Axial length: 22.73 mm. Woman.
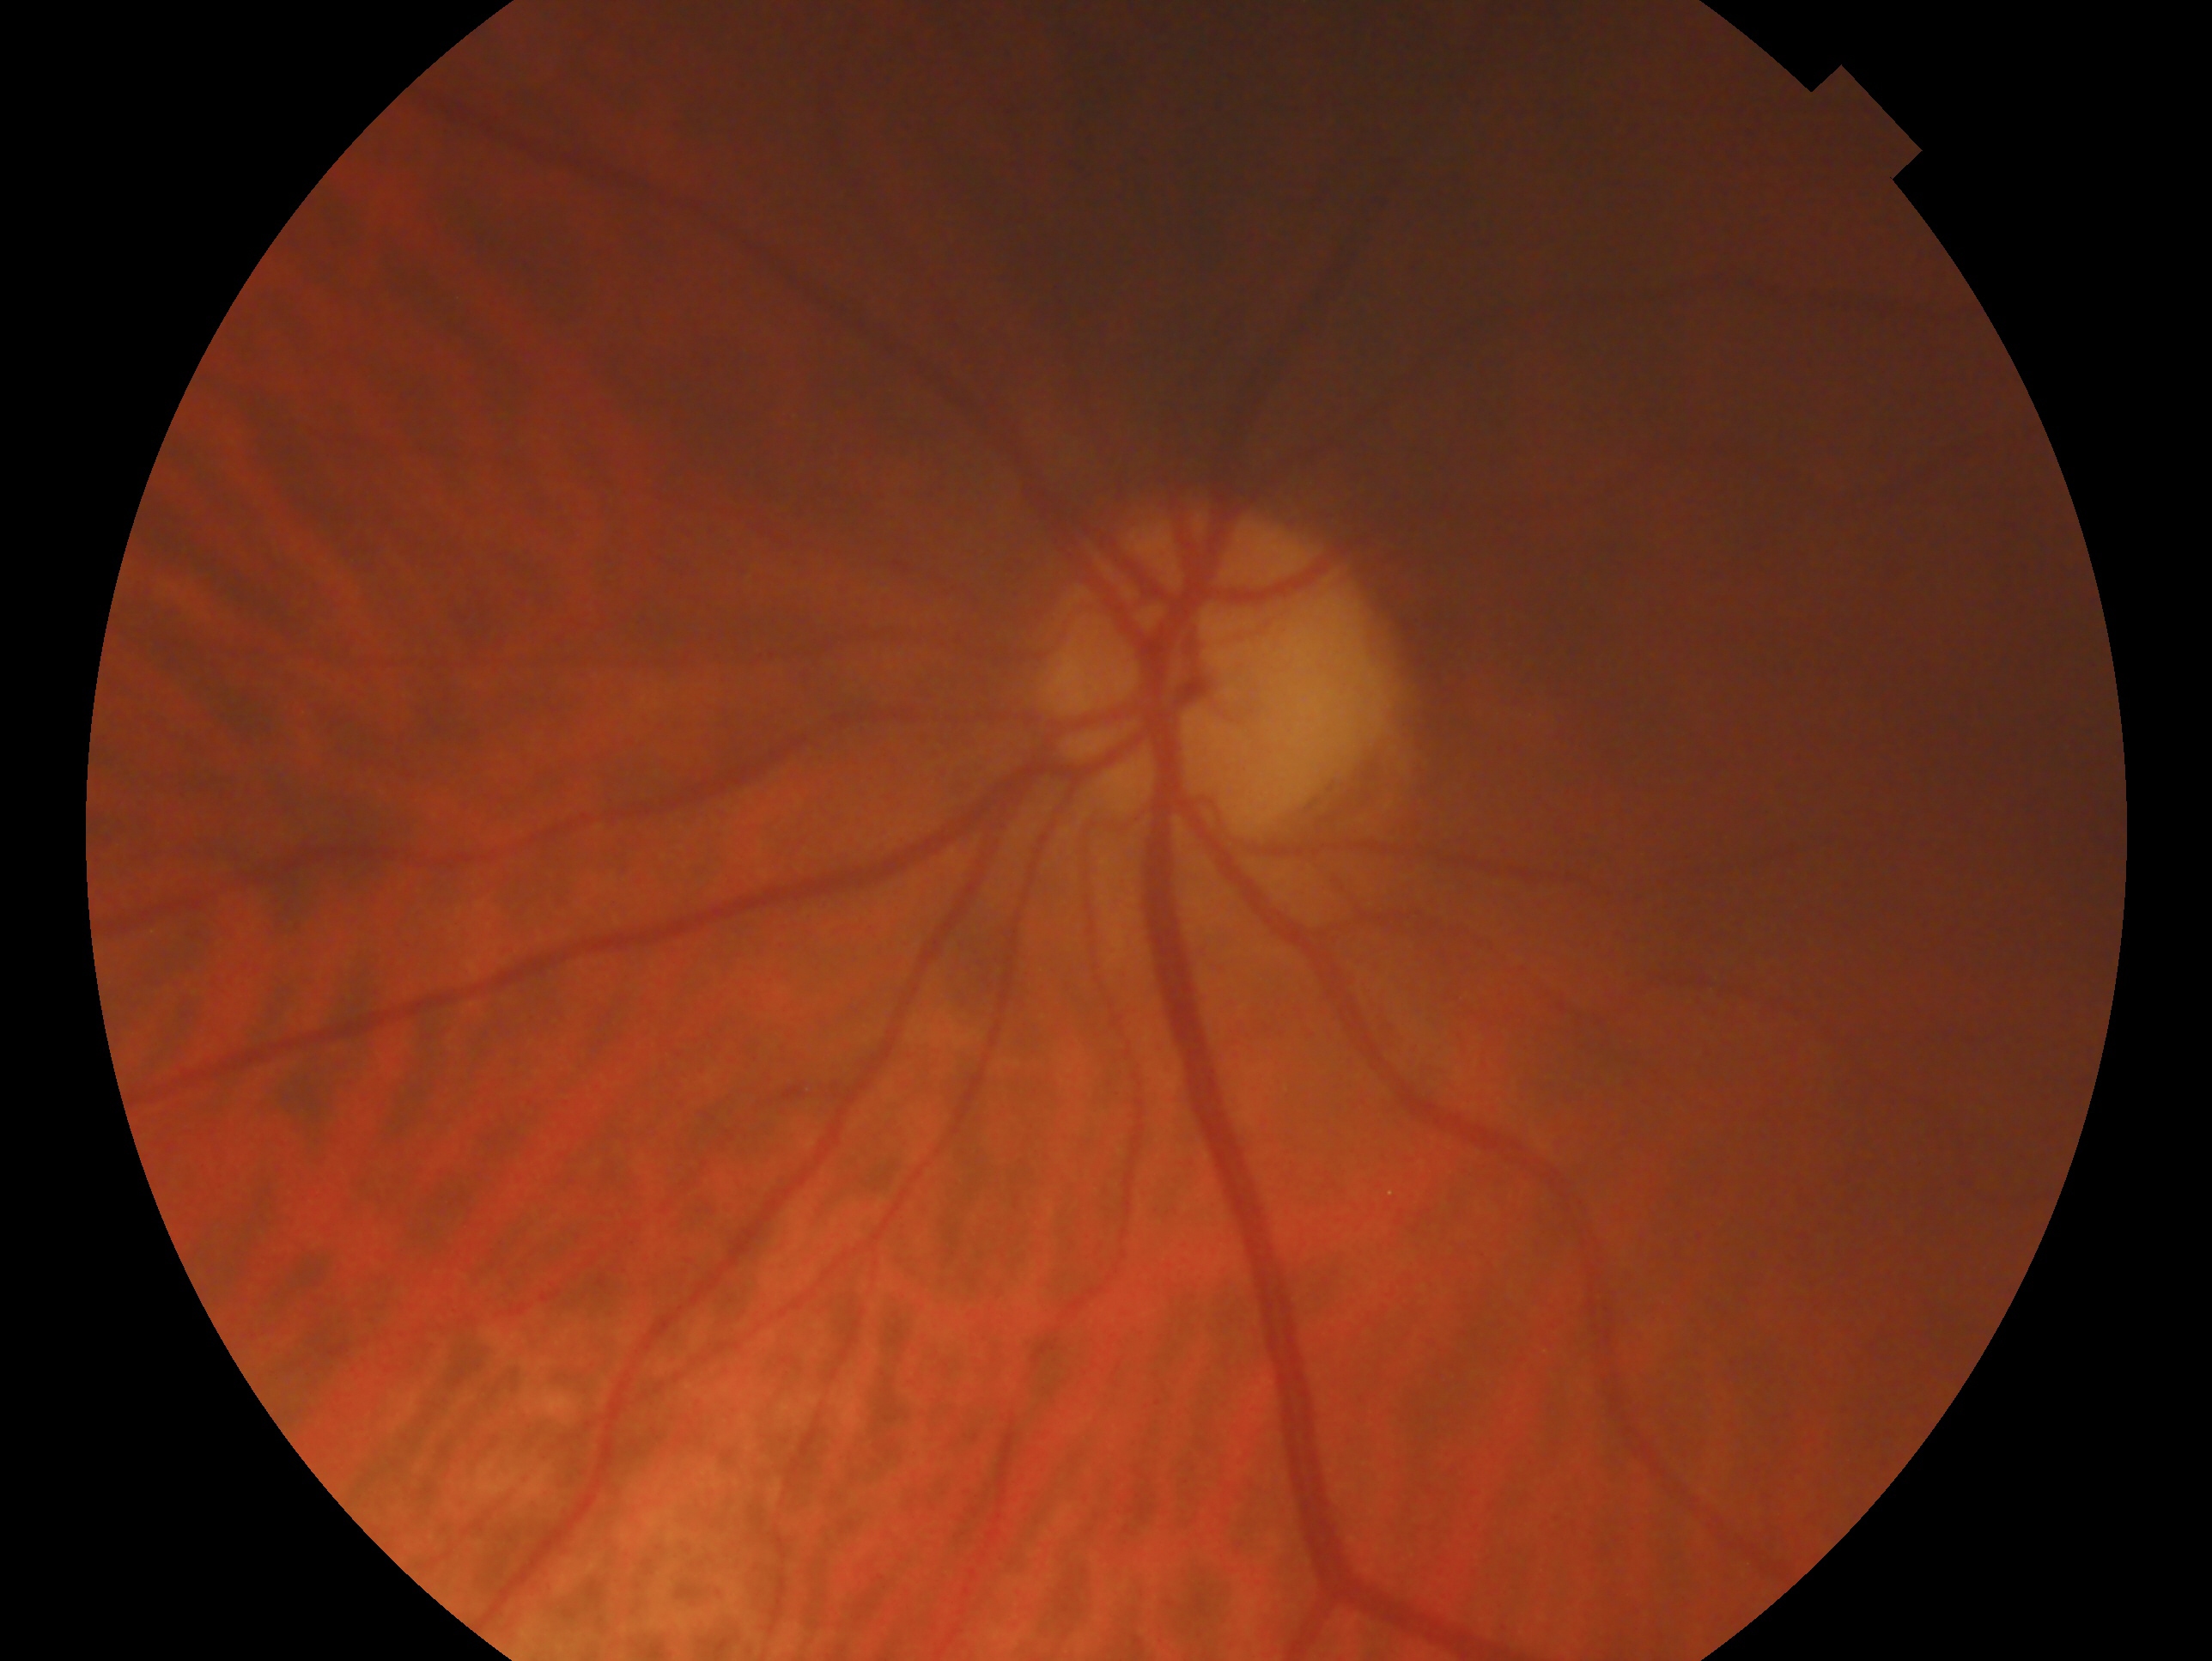 Assessment: no evidence of glaucoma. This is the left eye.